FOV: 50 degrees. Pupil-dilated. Camera: Topcon TRC-50DX
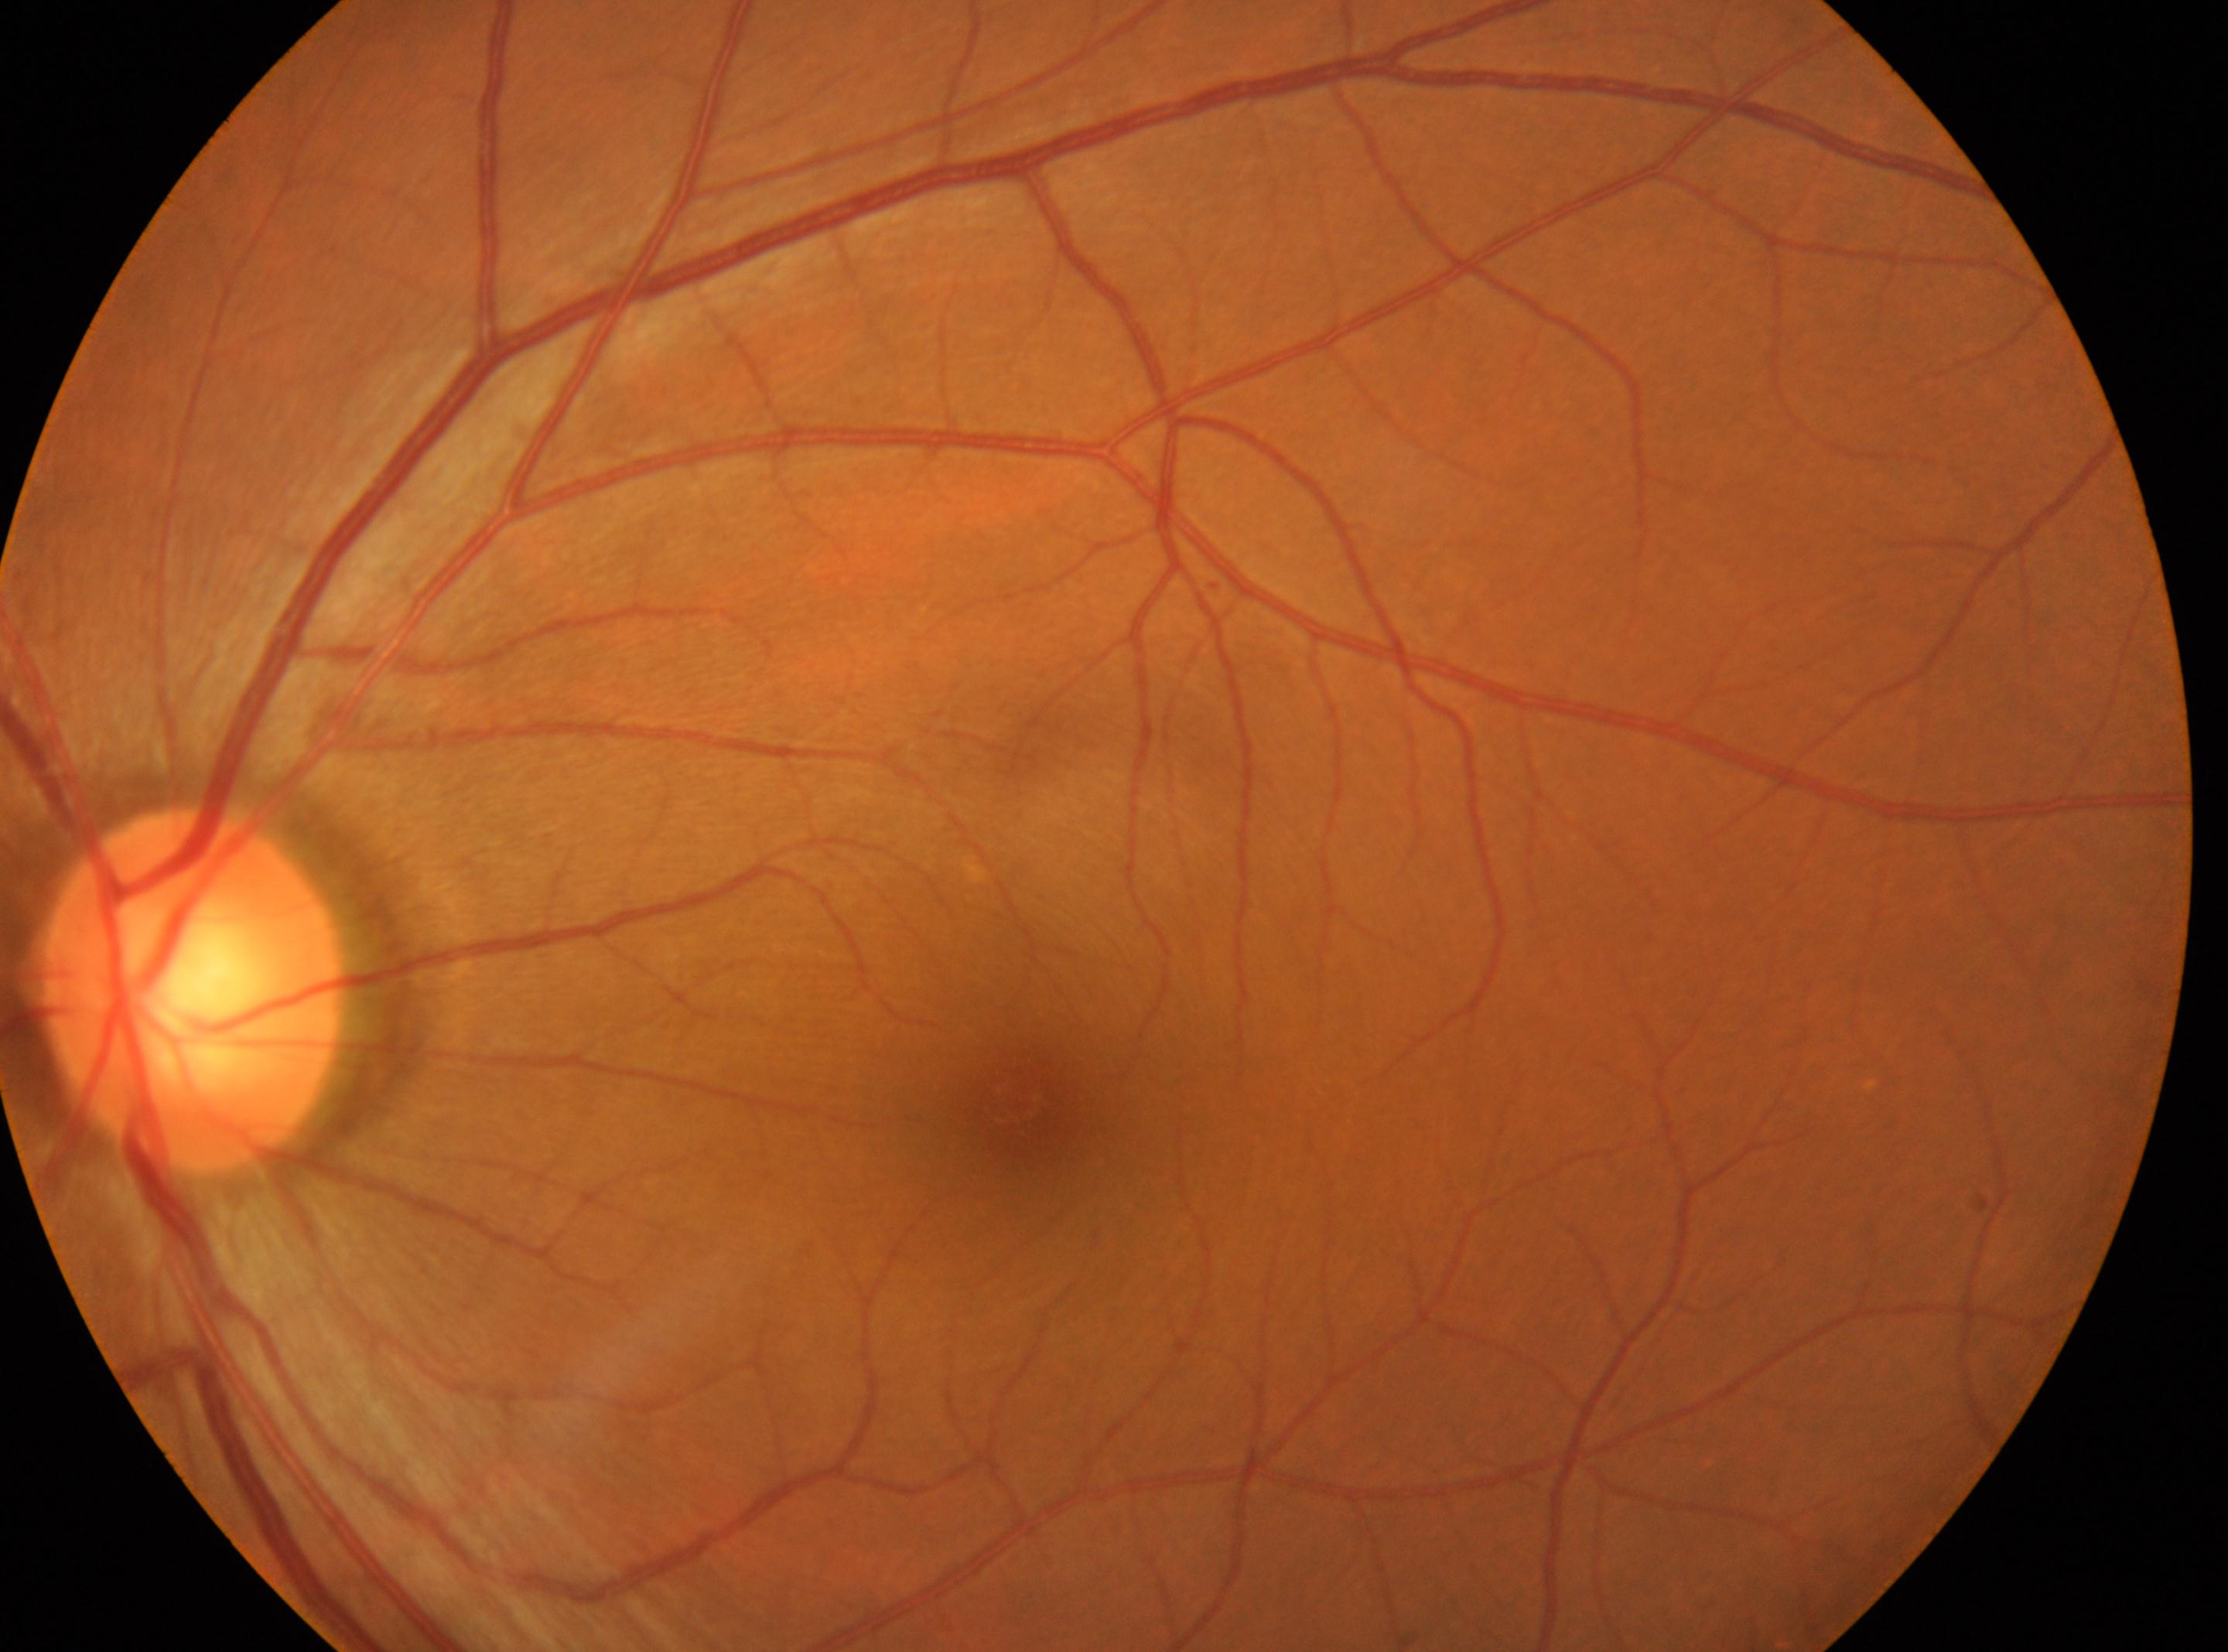
The image shows the left eye.
Diabetic retinopathy (DR) is grade 0.
Fovea center located at 1023px, 1103px.
The ONH is at 193px, 989px.